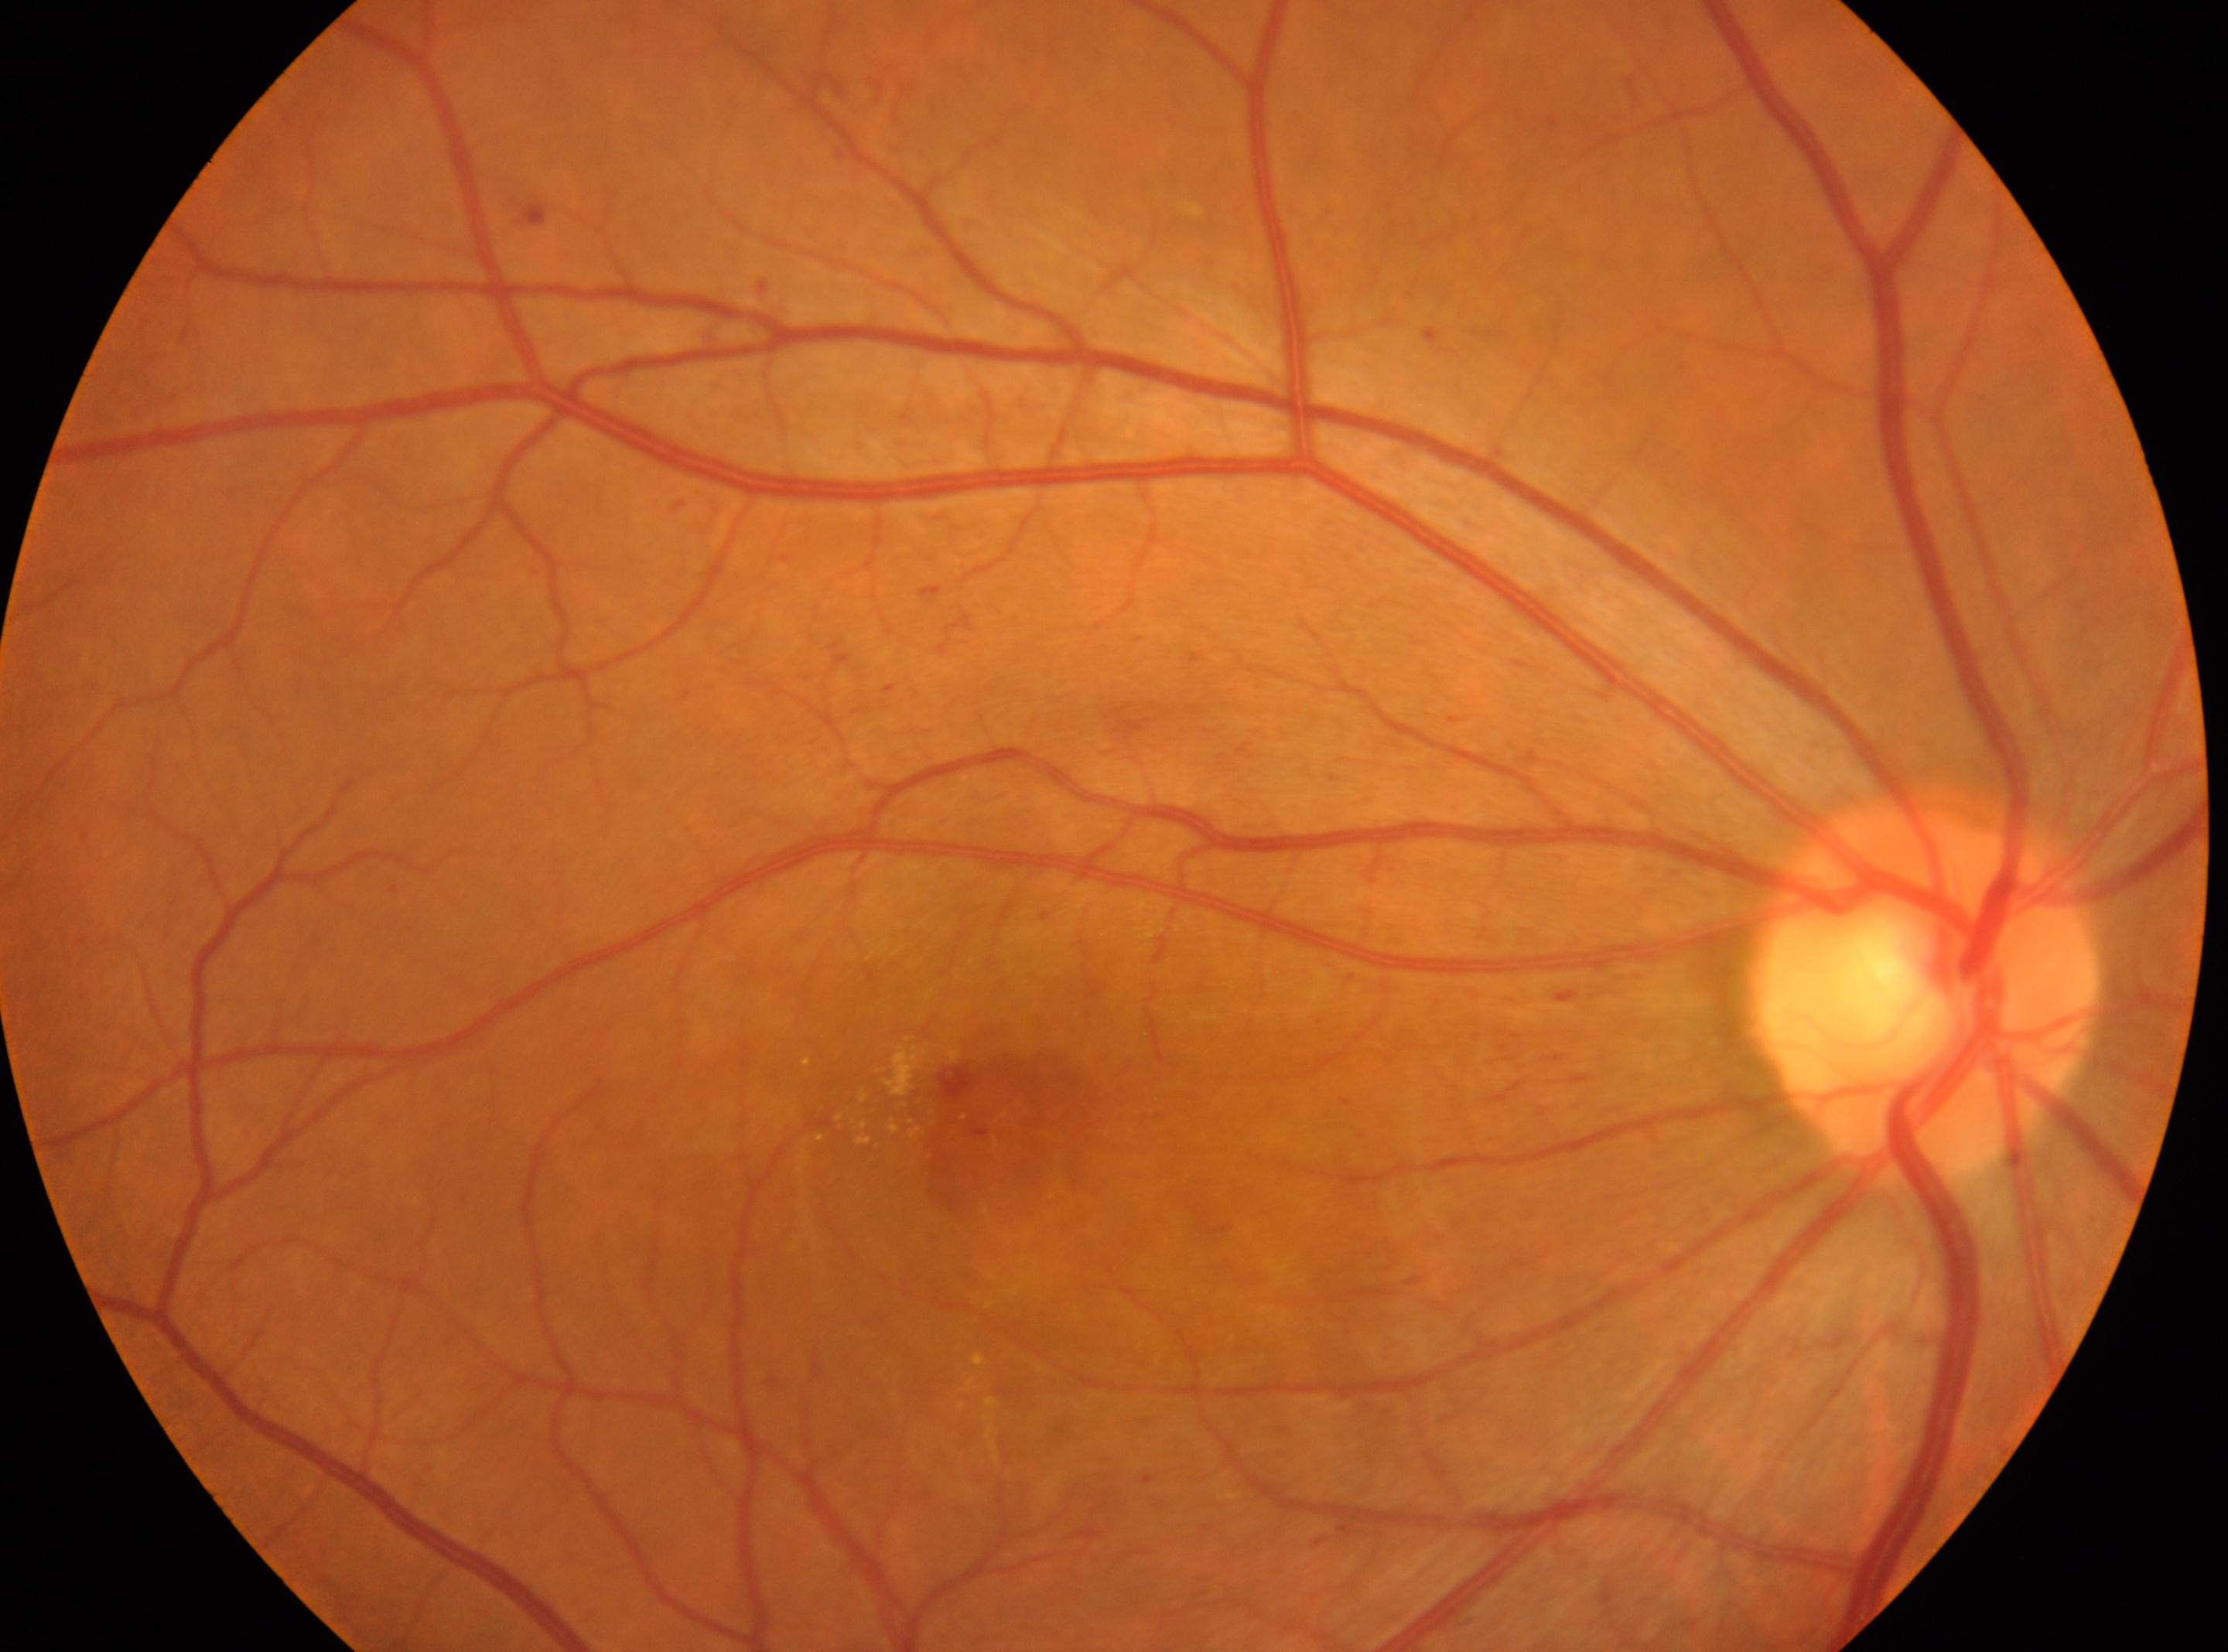
Q: Right or left eye?
A: oculus dexter
Q: Fovea center?
A: 1009px, 1123px
Q: Optic disc center?
A: 1923px, 991px
Q: DR stage?
A: 2 (moderate NPDR) — more than just microaneurysms but less than severe NPDR
Q: What disease class is present?
A: non-proliferative diabetic retinopathy